Retinal fundus photograph, image size 1659x2212 — 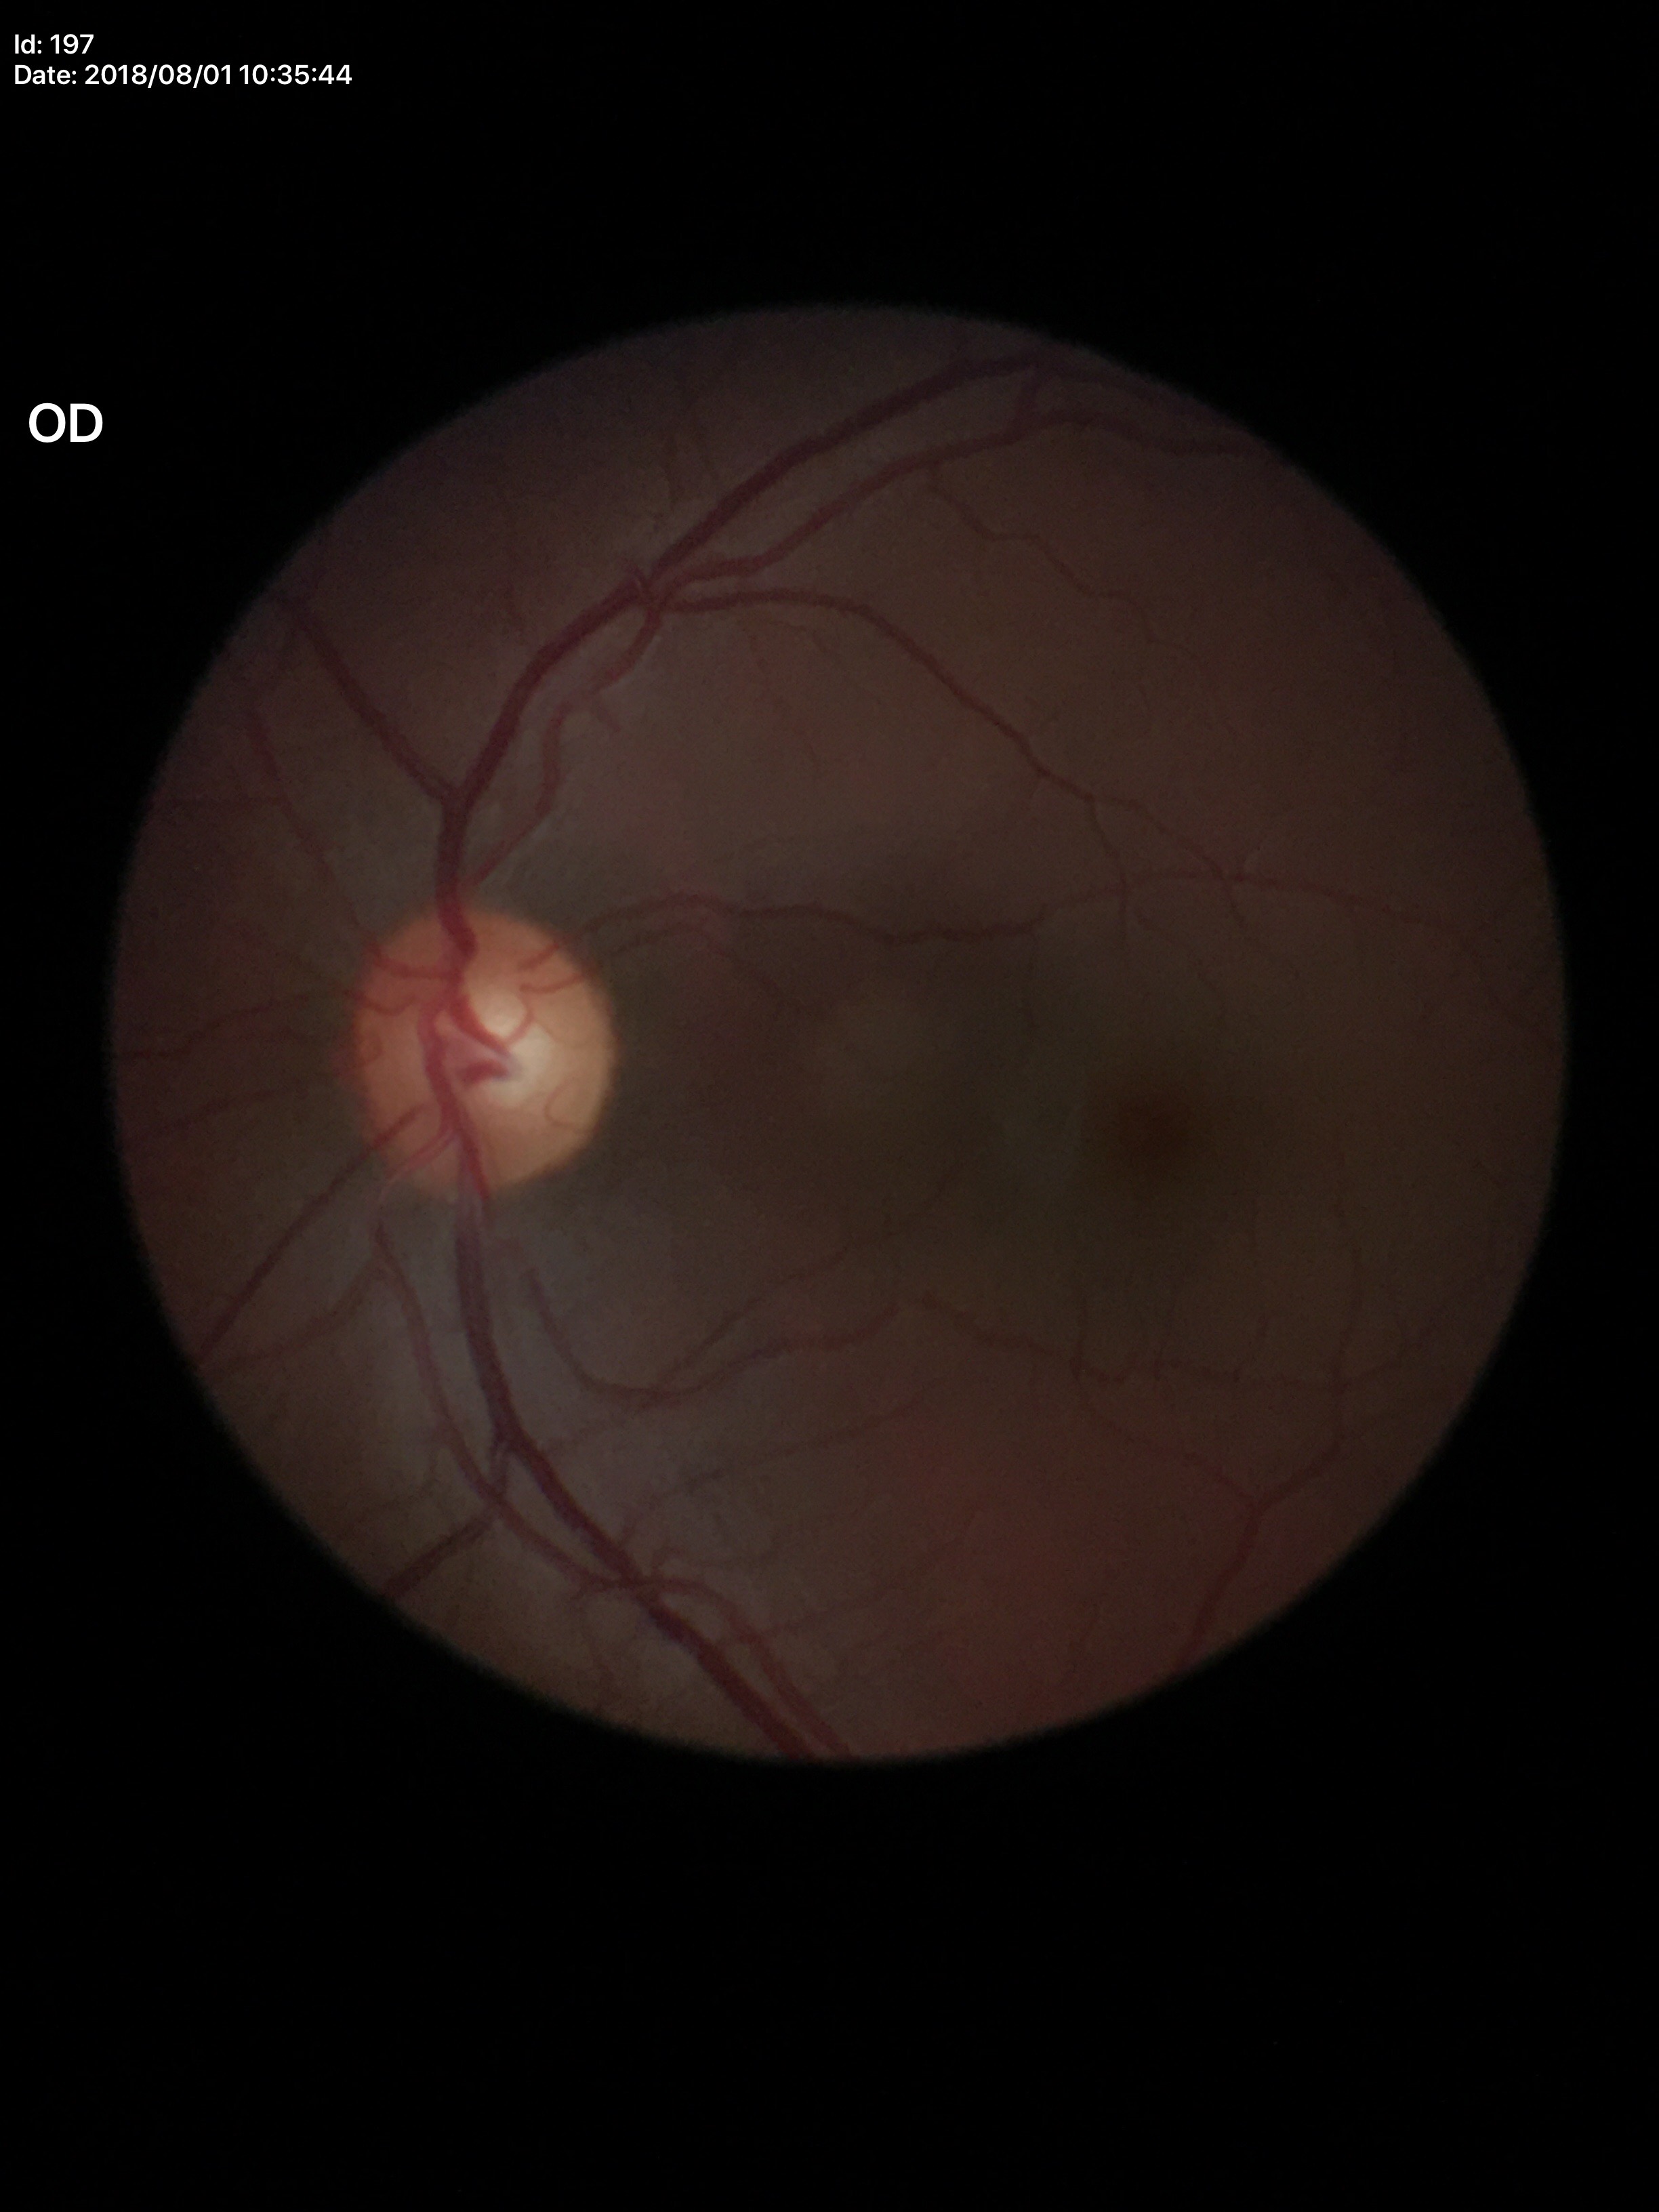

Glaucoma screening: negative; HCDR: 0.54; VCDR: 0.55